Without pupil dilation — 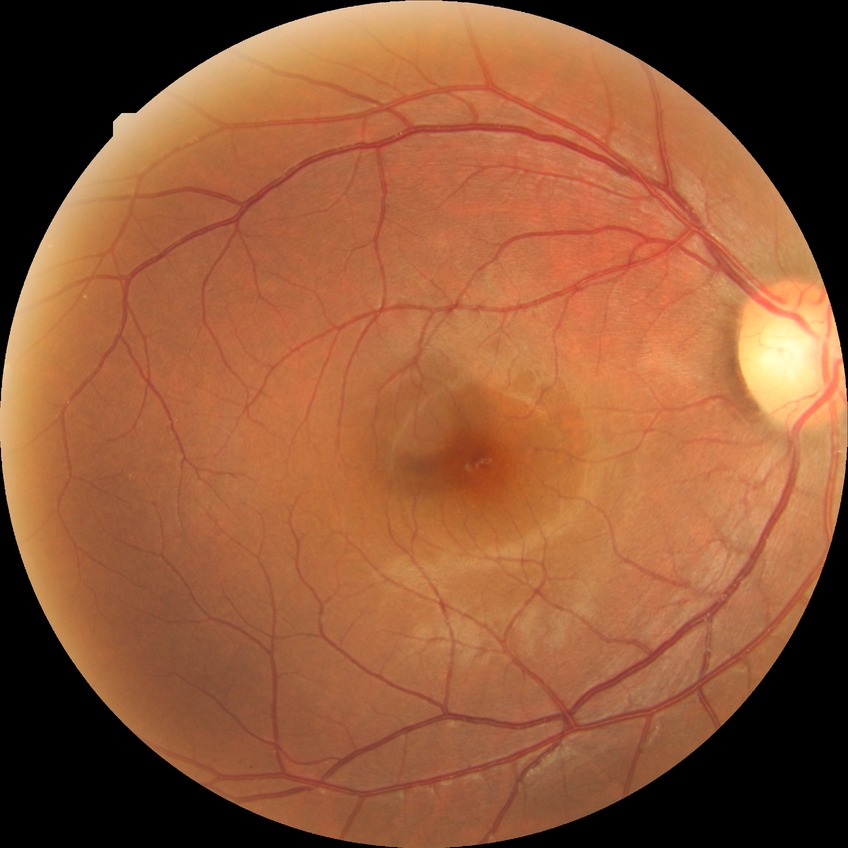
  davis_grade: no diabetic retinopathy